Dilated-pupil acquisition. Image size 2228x1652. Retinal fundus photograph. Posterior pole field covering the optic disc and macula. Acquired with a Topcon TRC-50DX
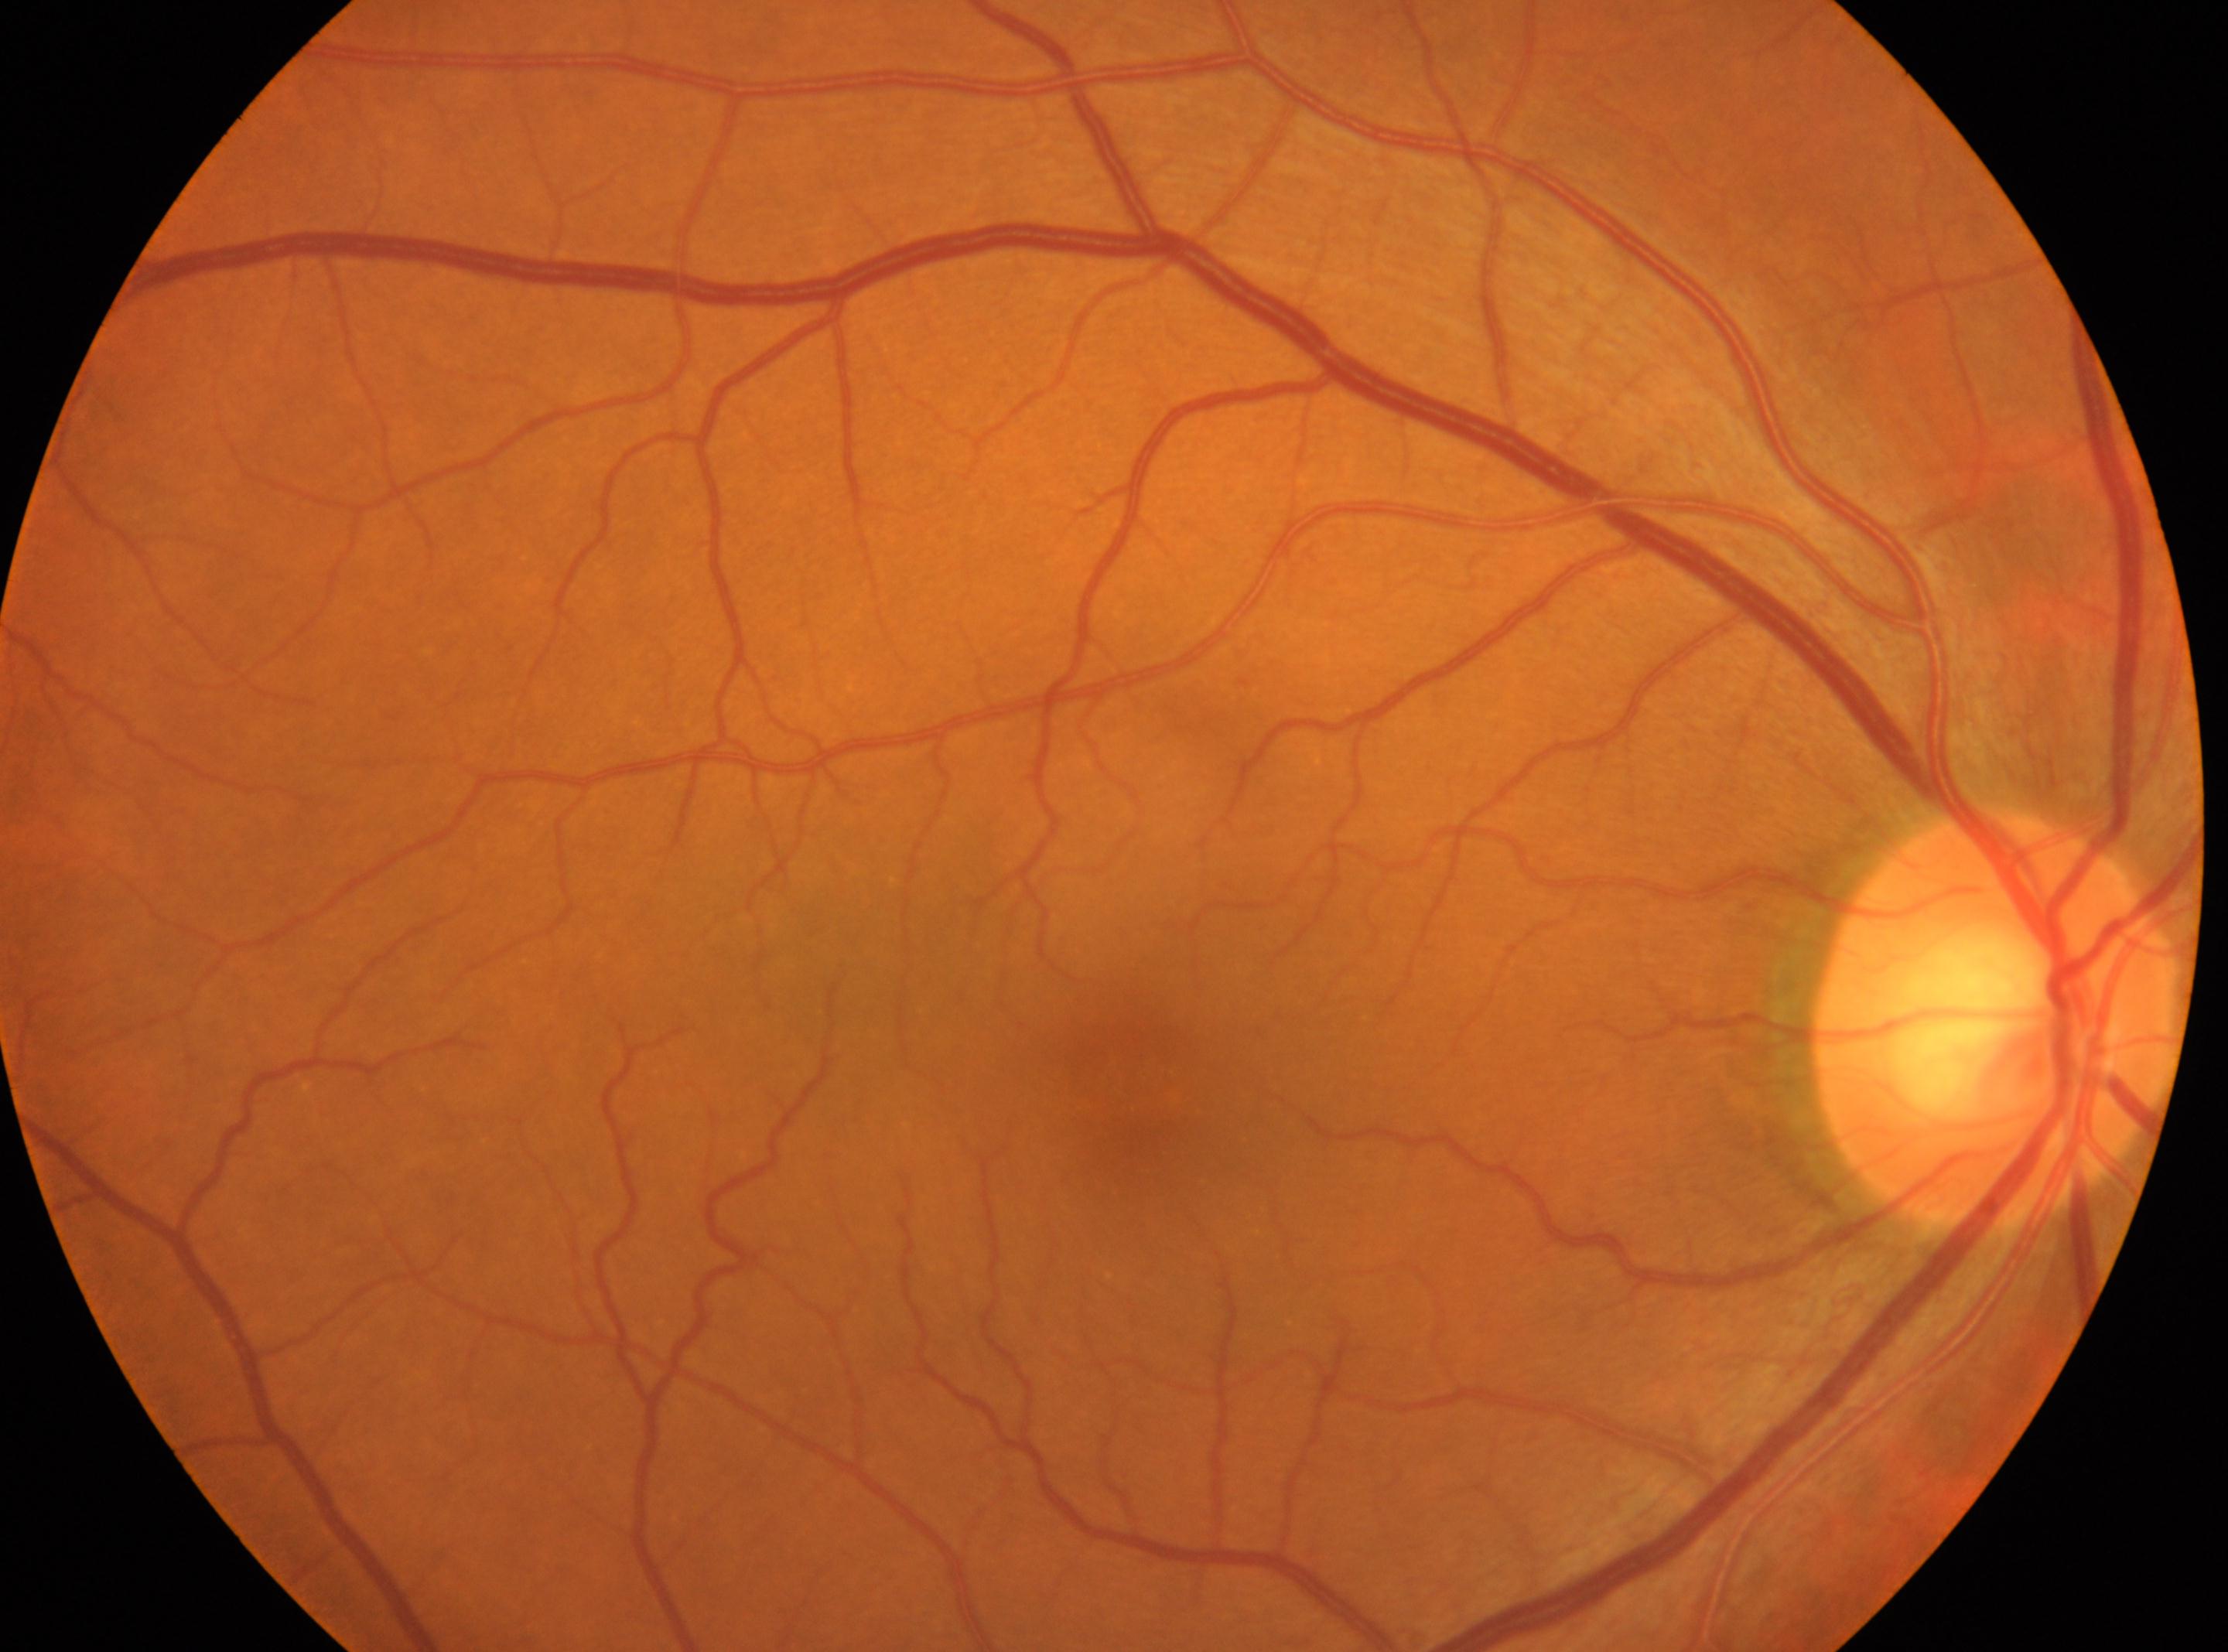
{
  "dr_grade": "0 (no apparent retinopathy)",
  "eye": "oculus dexter",
  "optic_disc": "(x: 1993, y: 1020)",
  "fovea": "(x: 1142, y: 1100)"
}